NIDEK AFC-230; FOV: 45 degrees; no pharmacologic dilation:
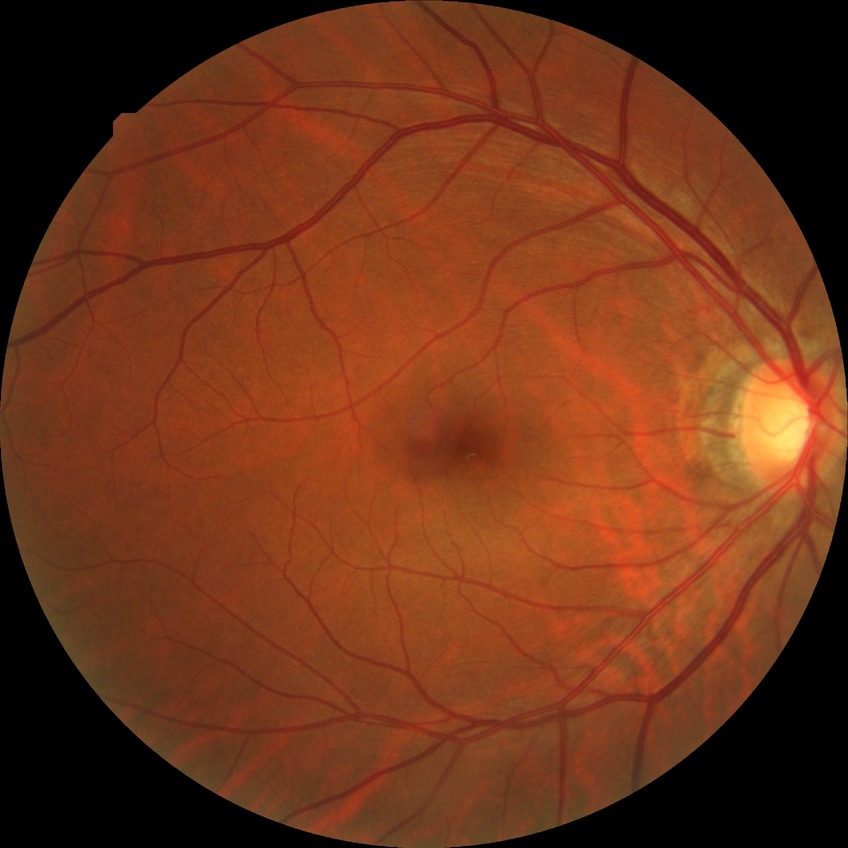
  davis_grade: SDR